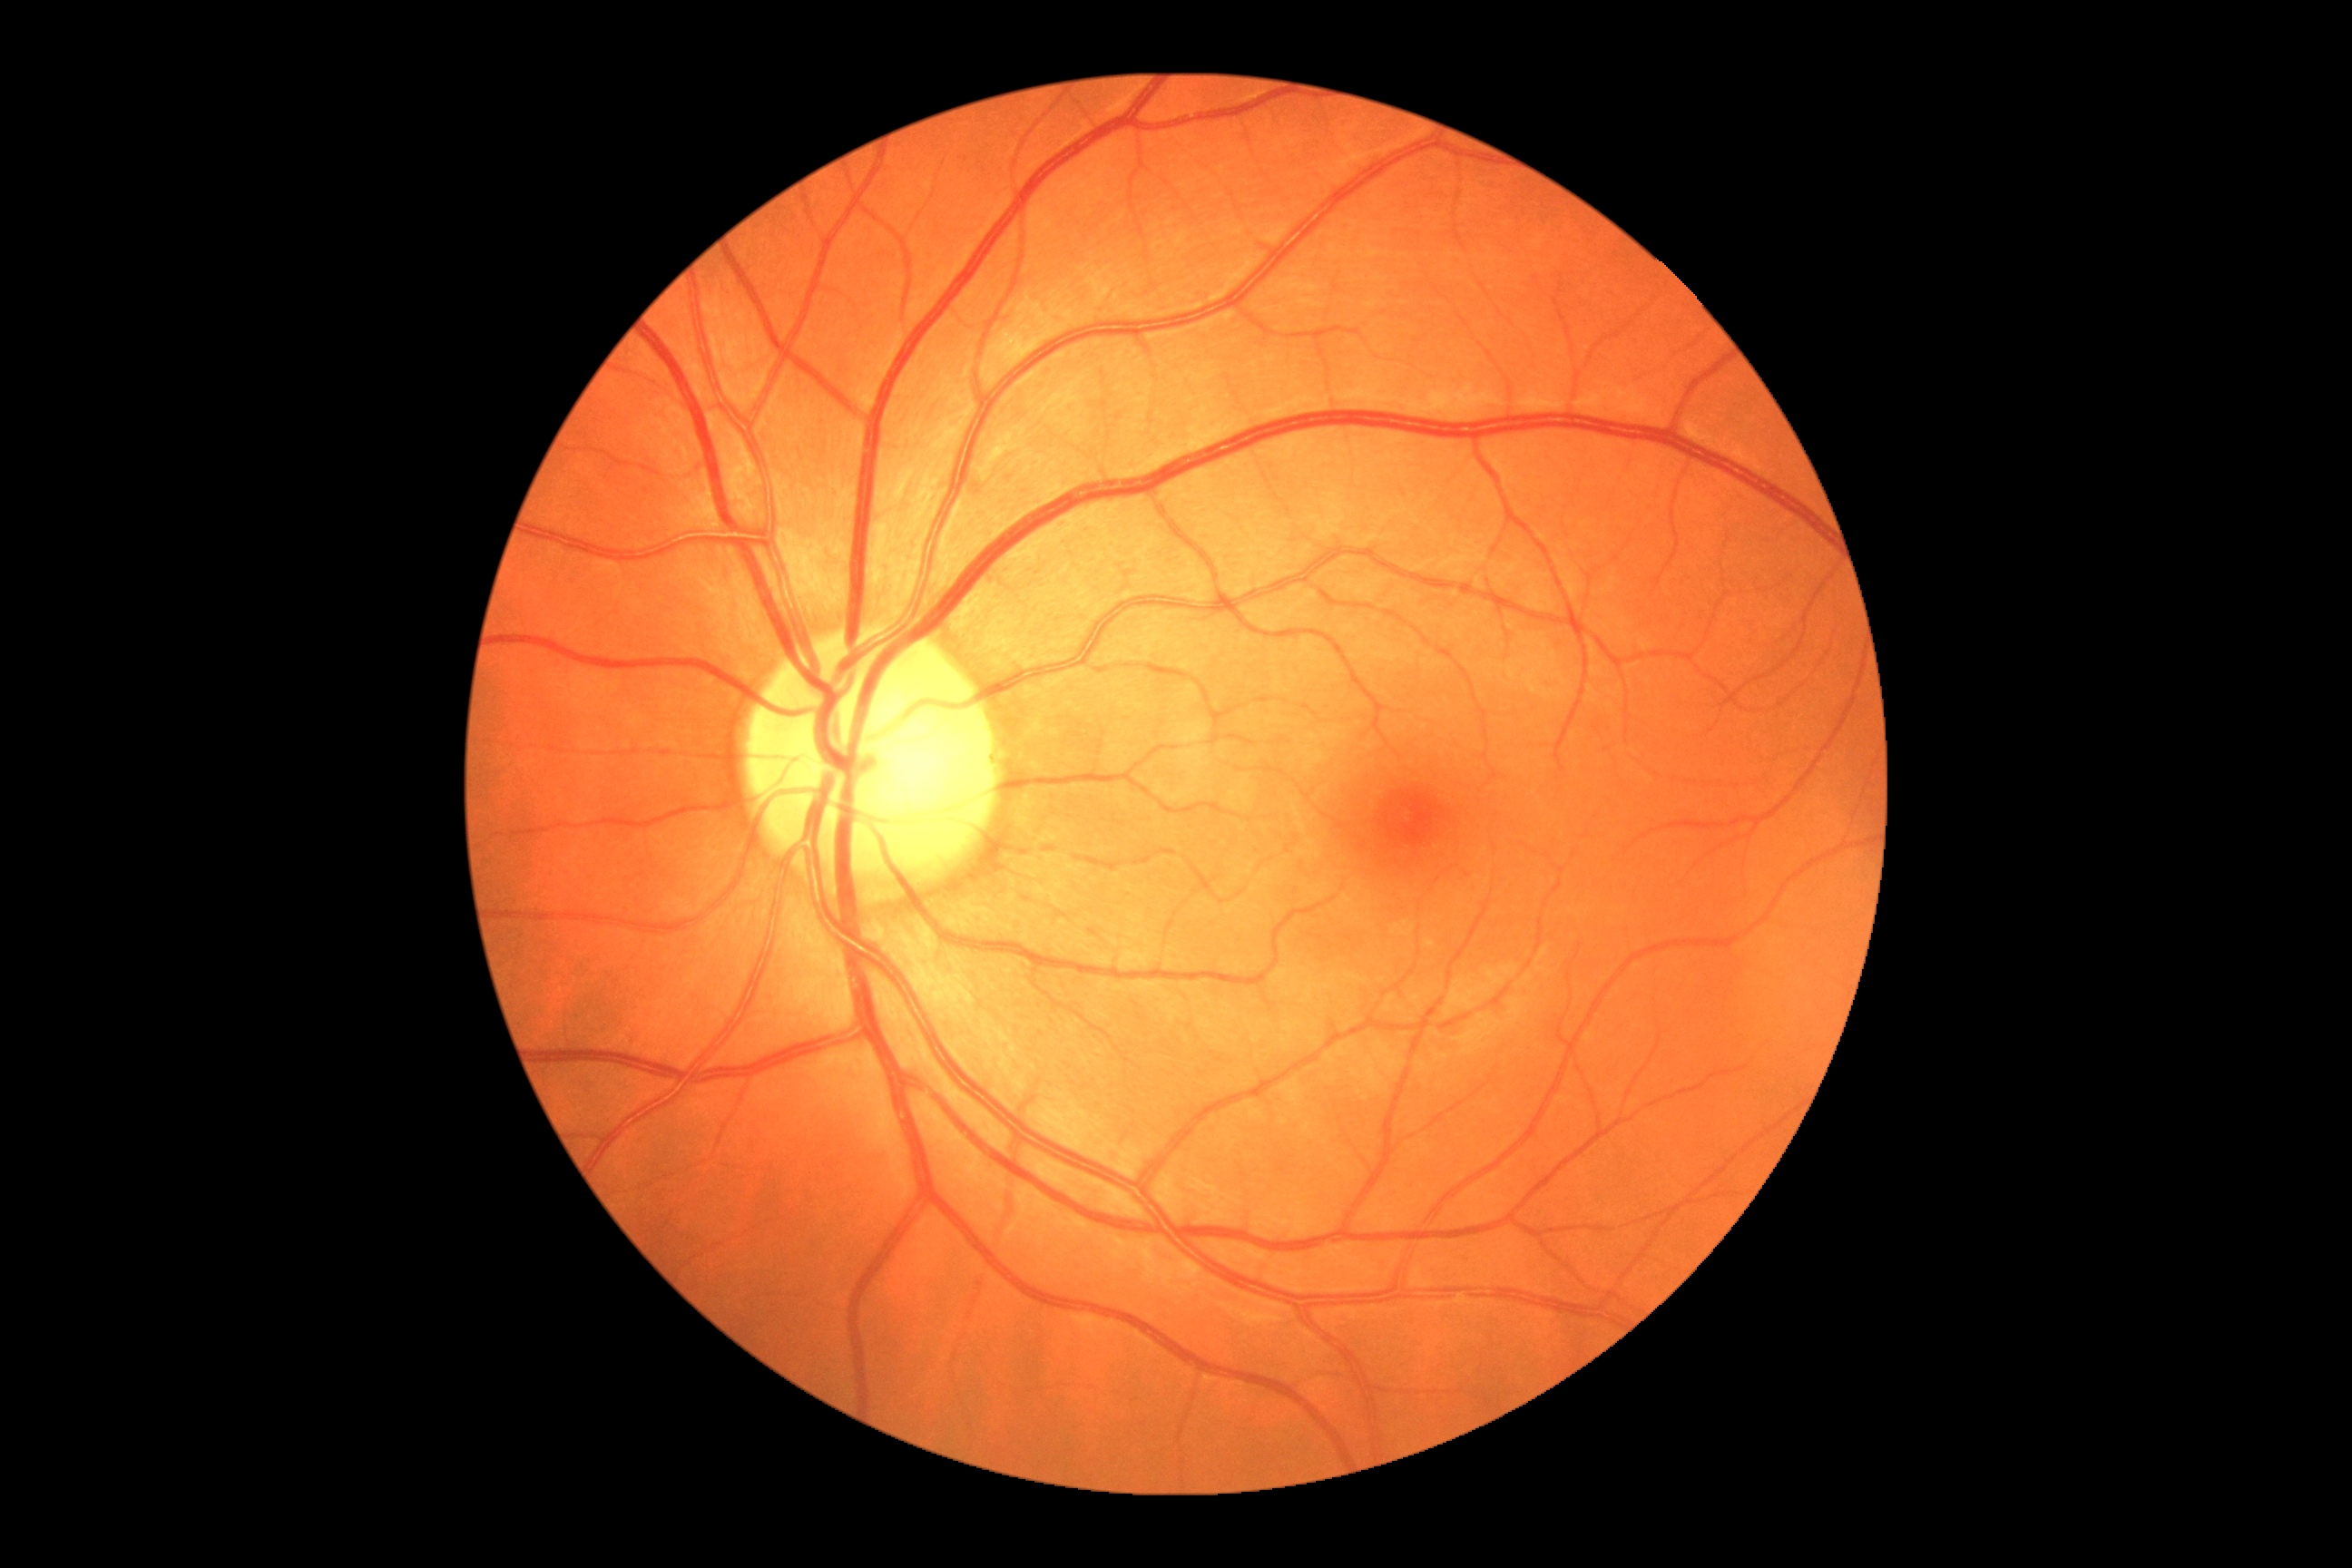

Diabetic retinopathy (DR): 0.